Davis DR grading; fundus photo — 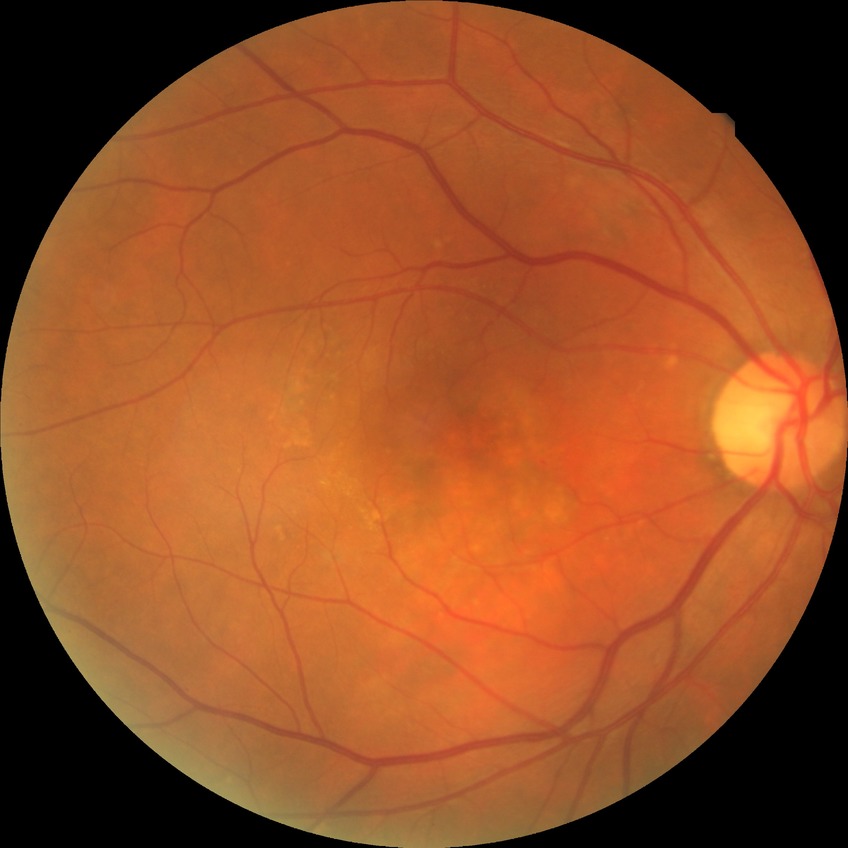 {
  "davis_grade": "NDR (no diabetic retinopathy)"
}